Retinal fundus photograph: 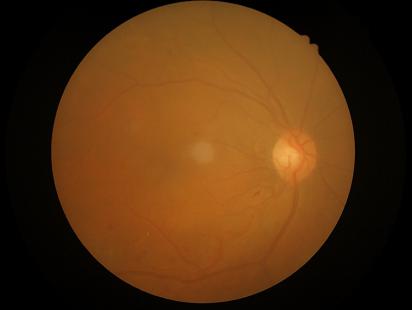 Contrast = low | Illumination/color = satisfactory | Overall image quality = inadequate | Sharpness = out of focus.